UWF retinal mosaic.
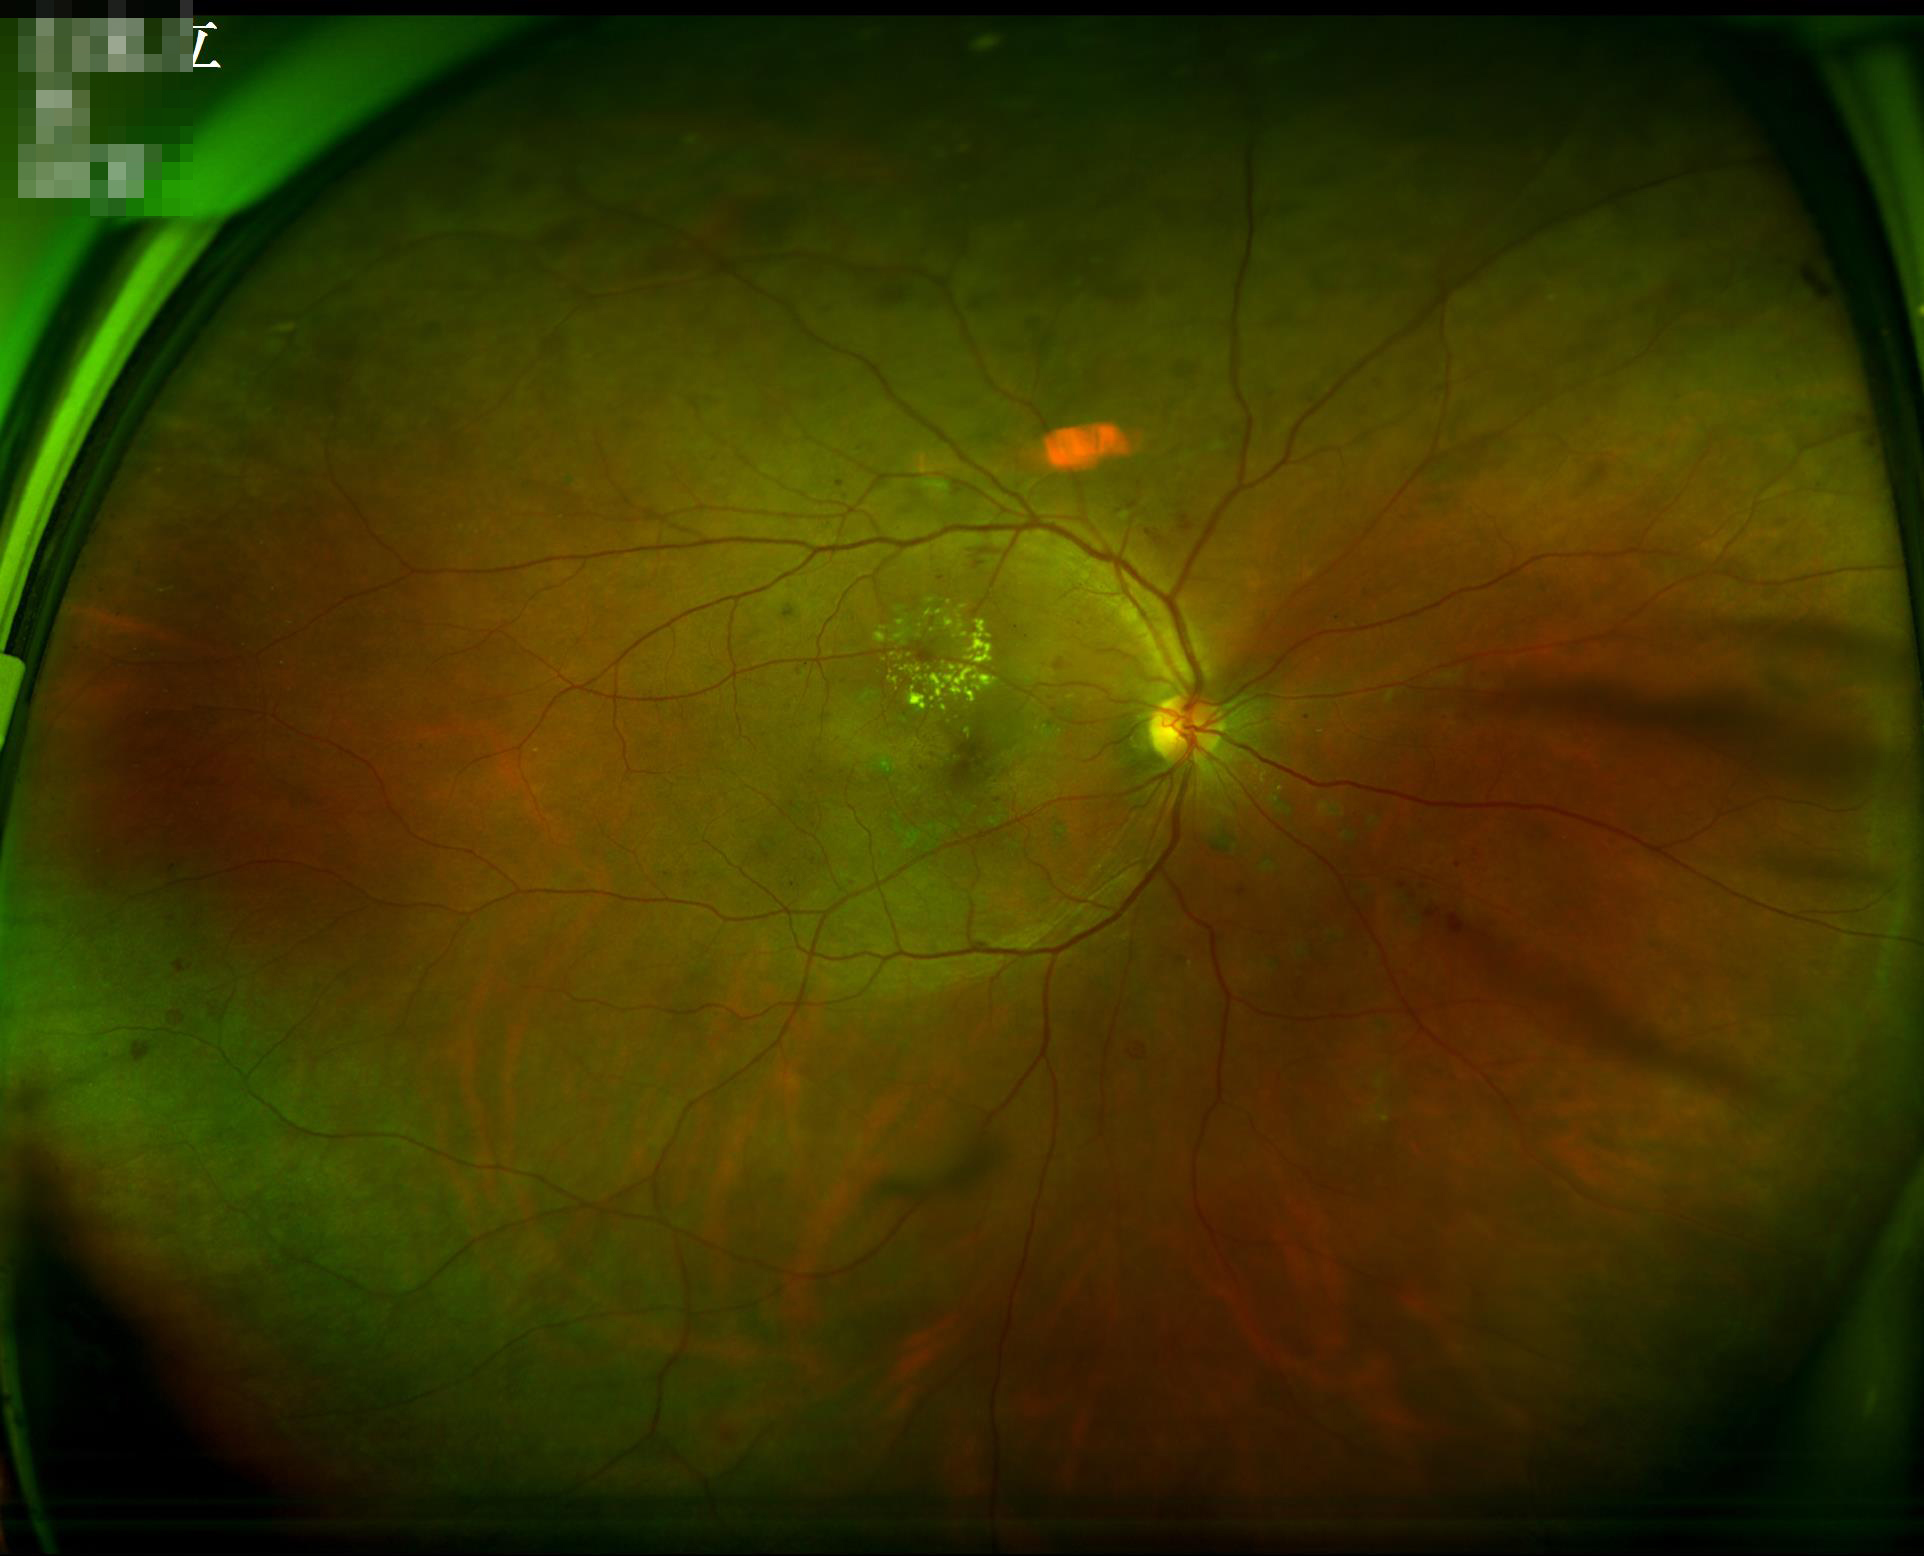
Image quality: overall: good, gradable | illumination/color: uniform, no color cast | contrast: good dynamic range | clarity: sharp throughout the field.